Color fundus image, 1659 by 2212 pixels.
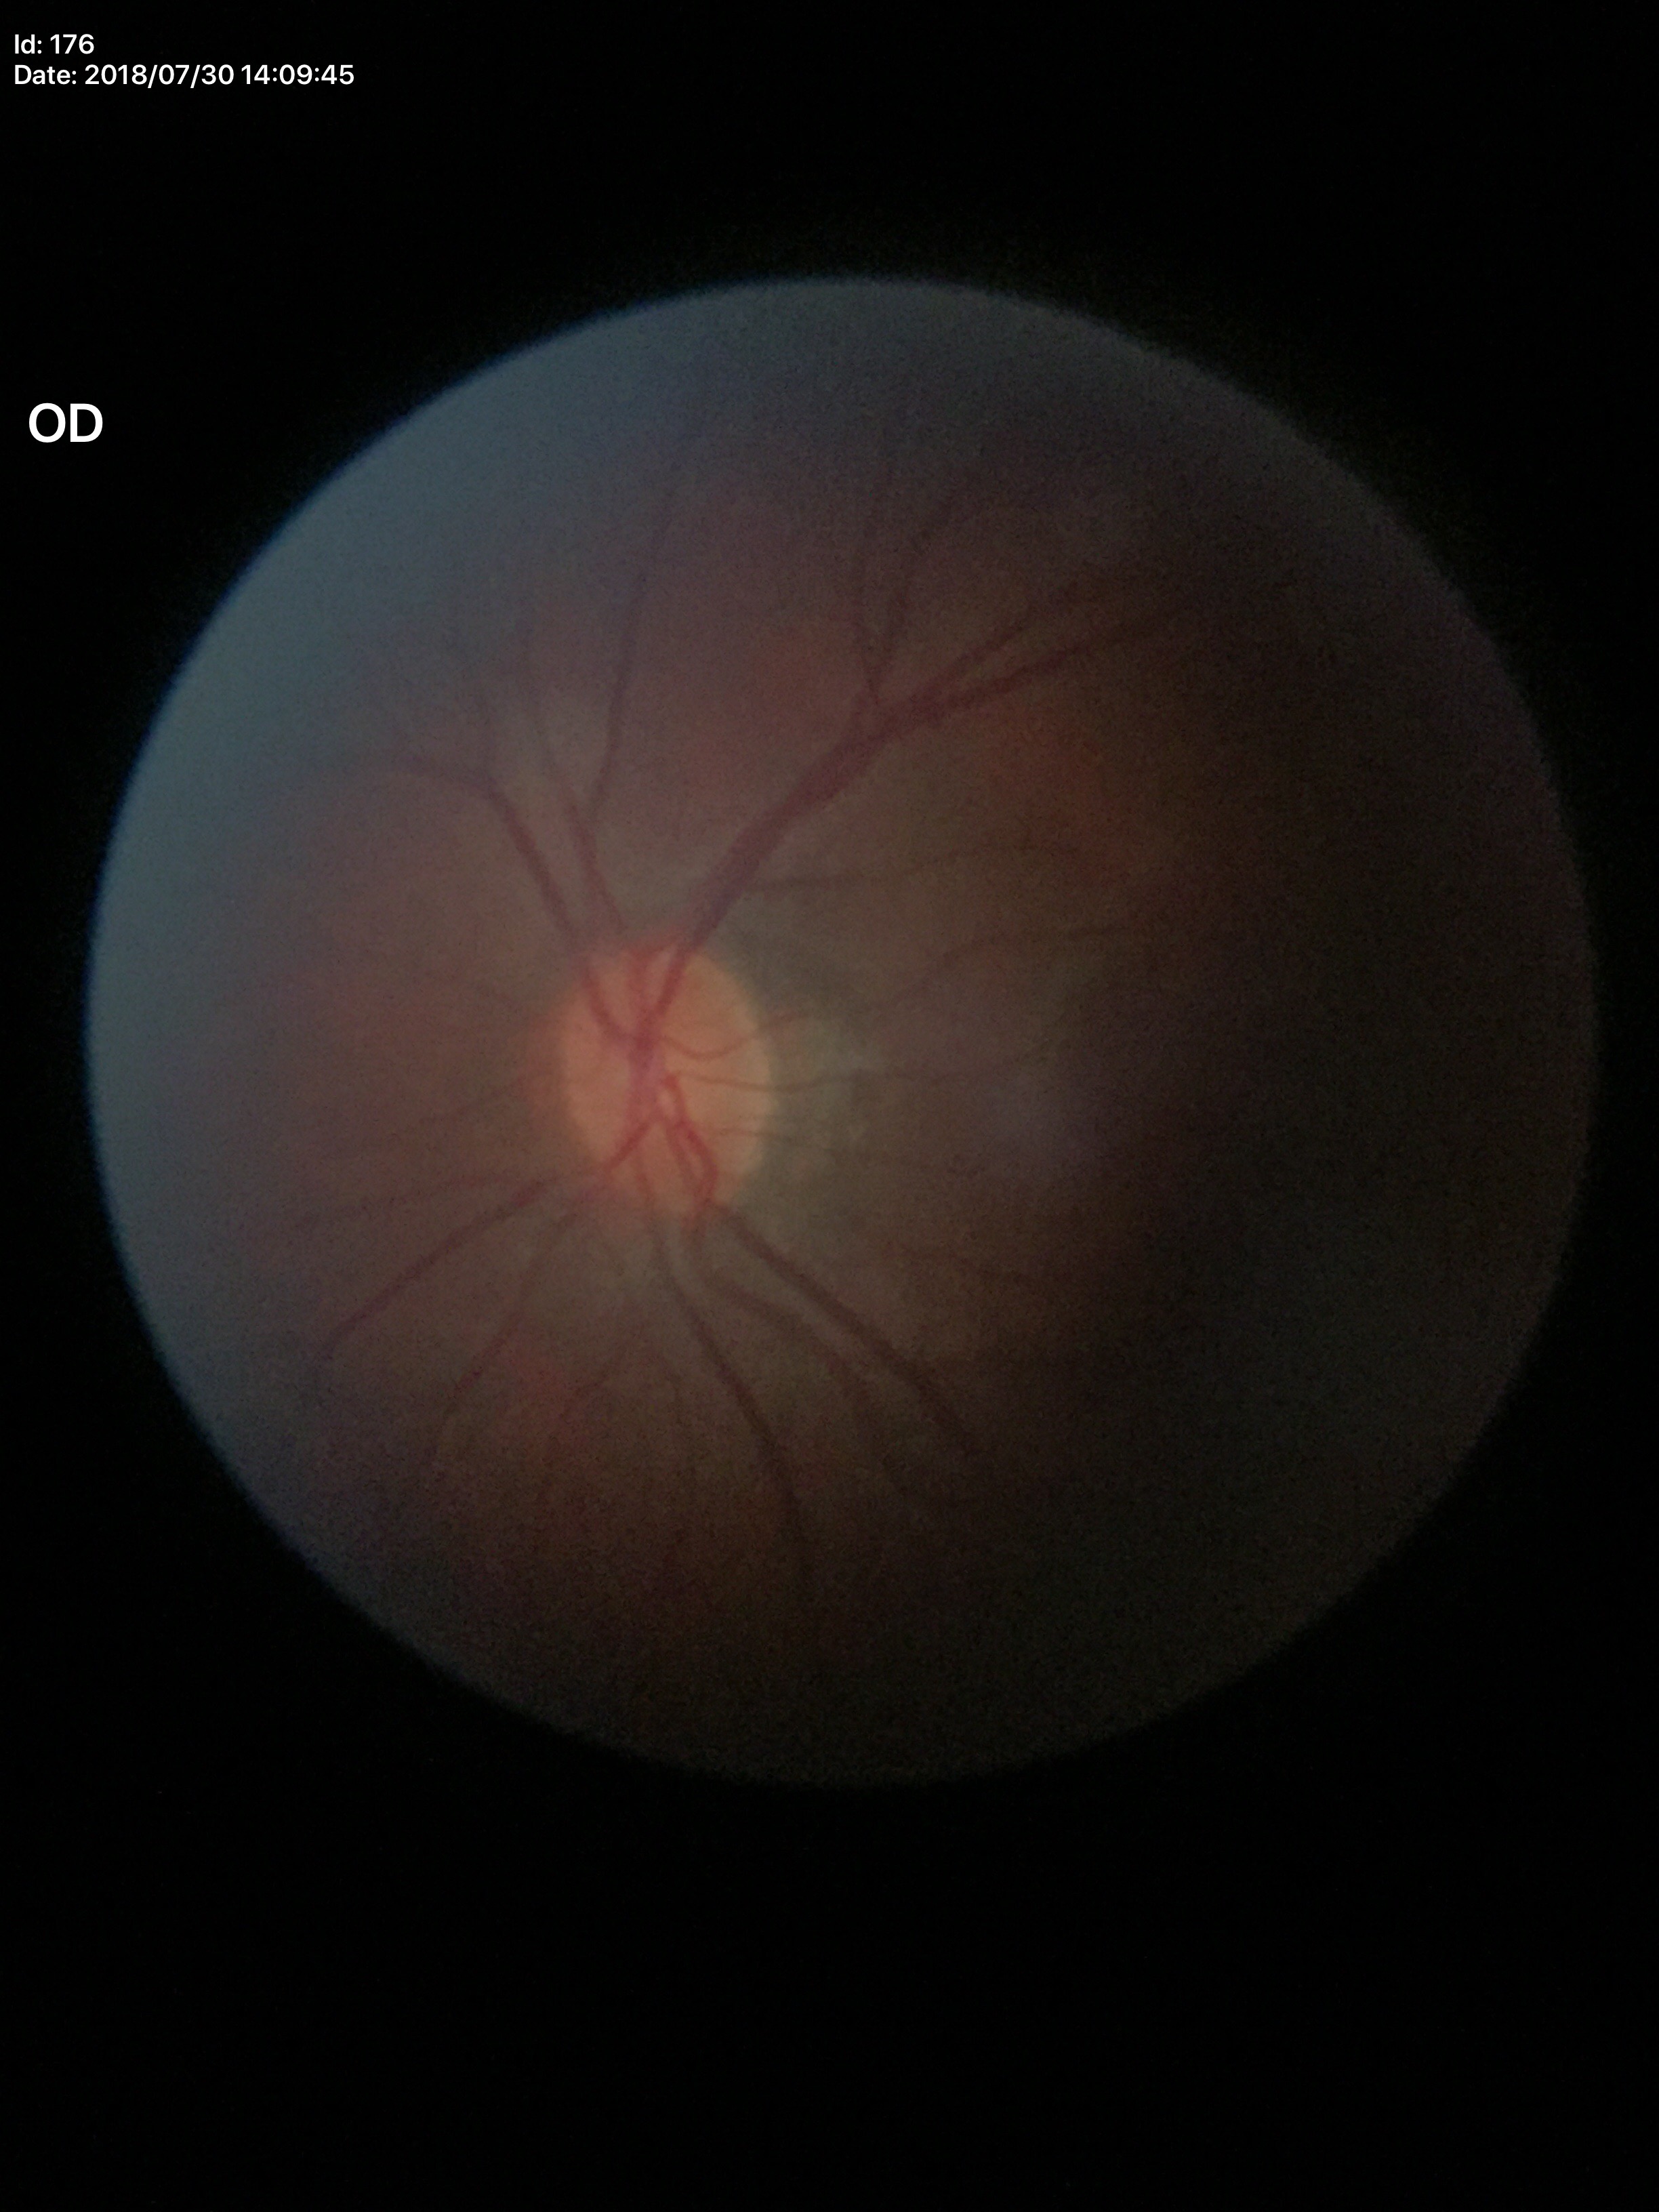 Glaucoma screening: negative
vertical cup-to-disc ratio: 0.46